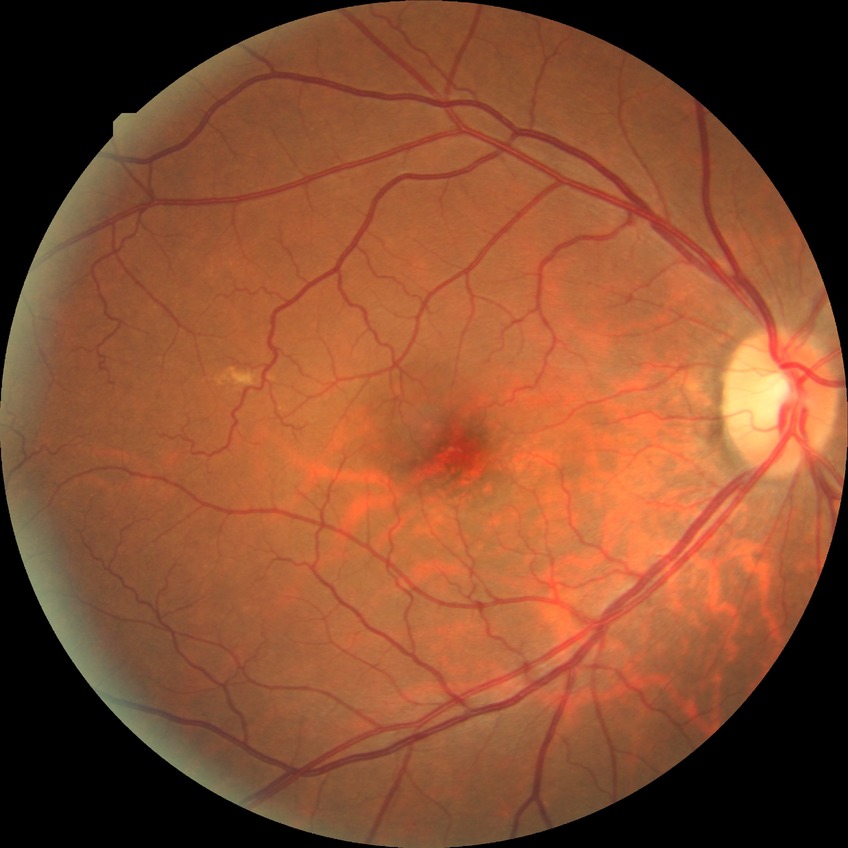
Diabetic retinopathy (DR) is NDR (no diabetic retinopathy).